Color fundus photograph, 45 degree fundus photograph, graded on the modified Davis scale — 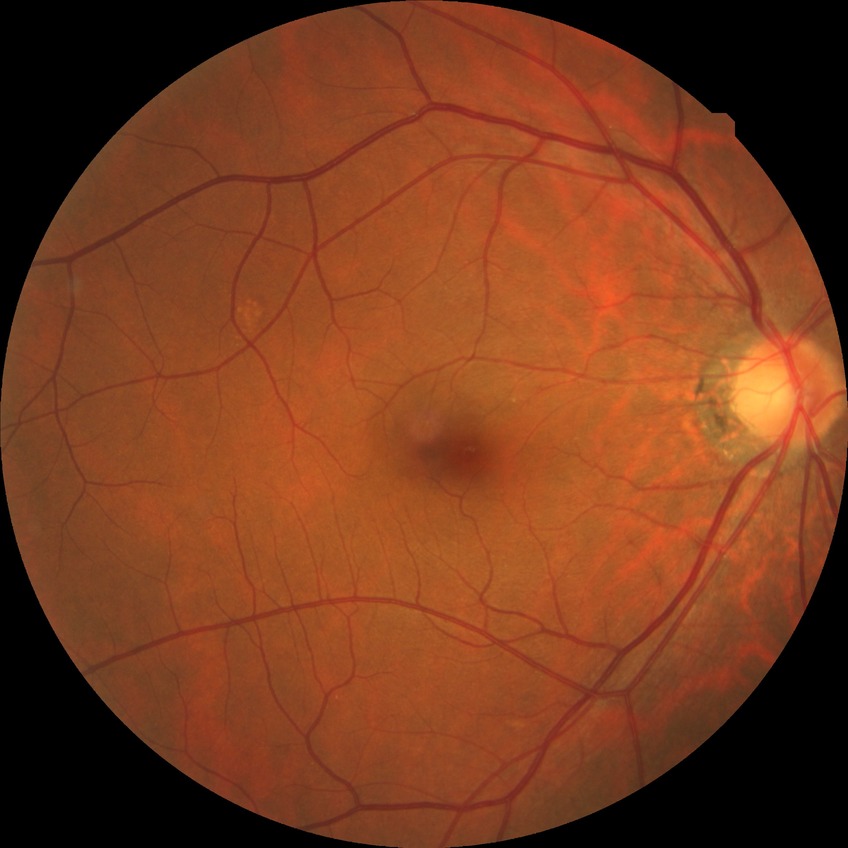
Diabetic retinopathy (DR) is NDR (no diabetic retinopathy).